Retinal fundus photograph. Without pupil dilation. Acquired with a NIDEK AFC-230. 848 x 848 pixels. 45 degree fundus photograph.
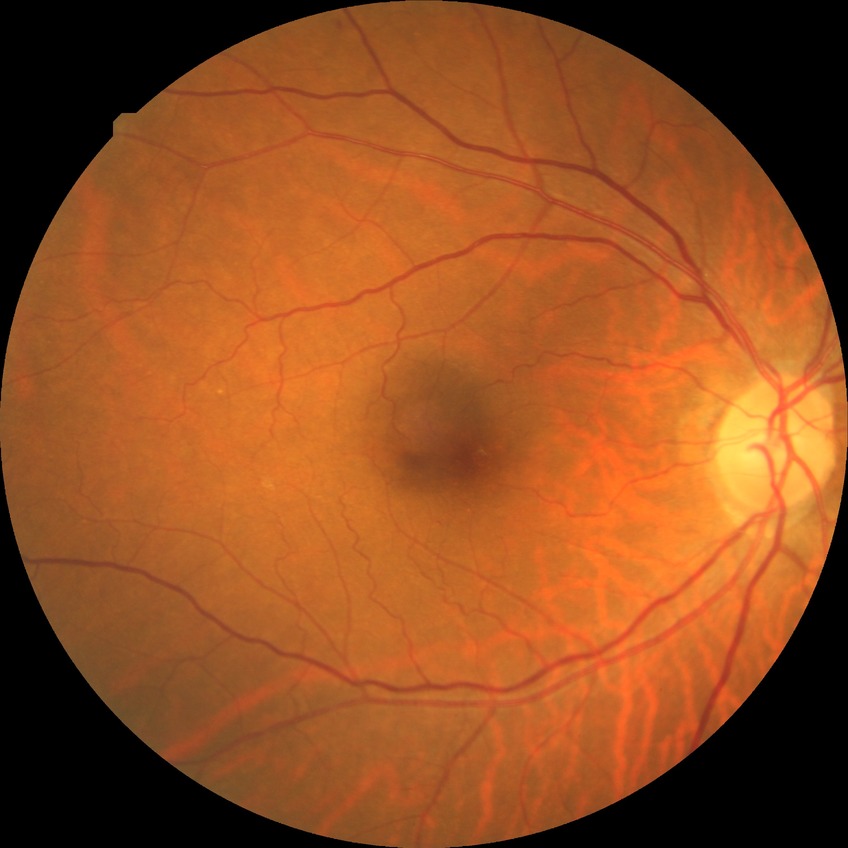 Modified Davis grade: NDR. No apparent diabetic retinopathy.